2361 x 1568 pixels; centered on the macula; fundus photo; captured after pupil dilation
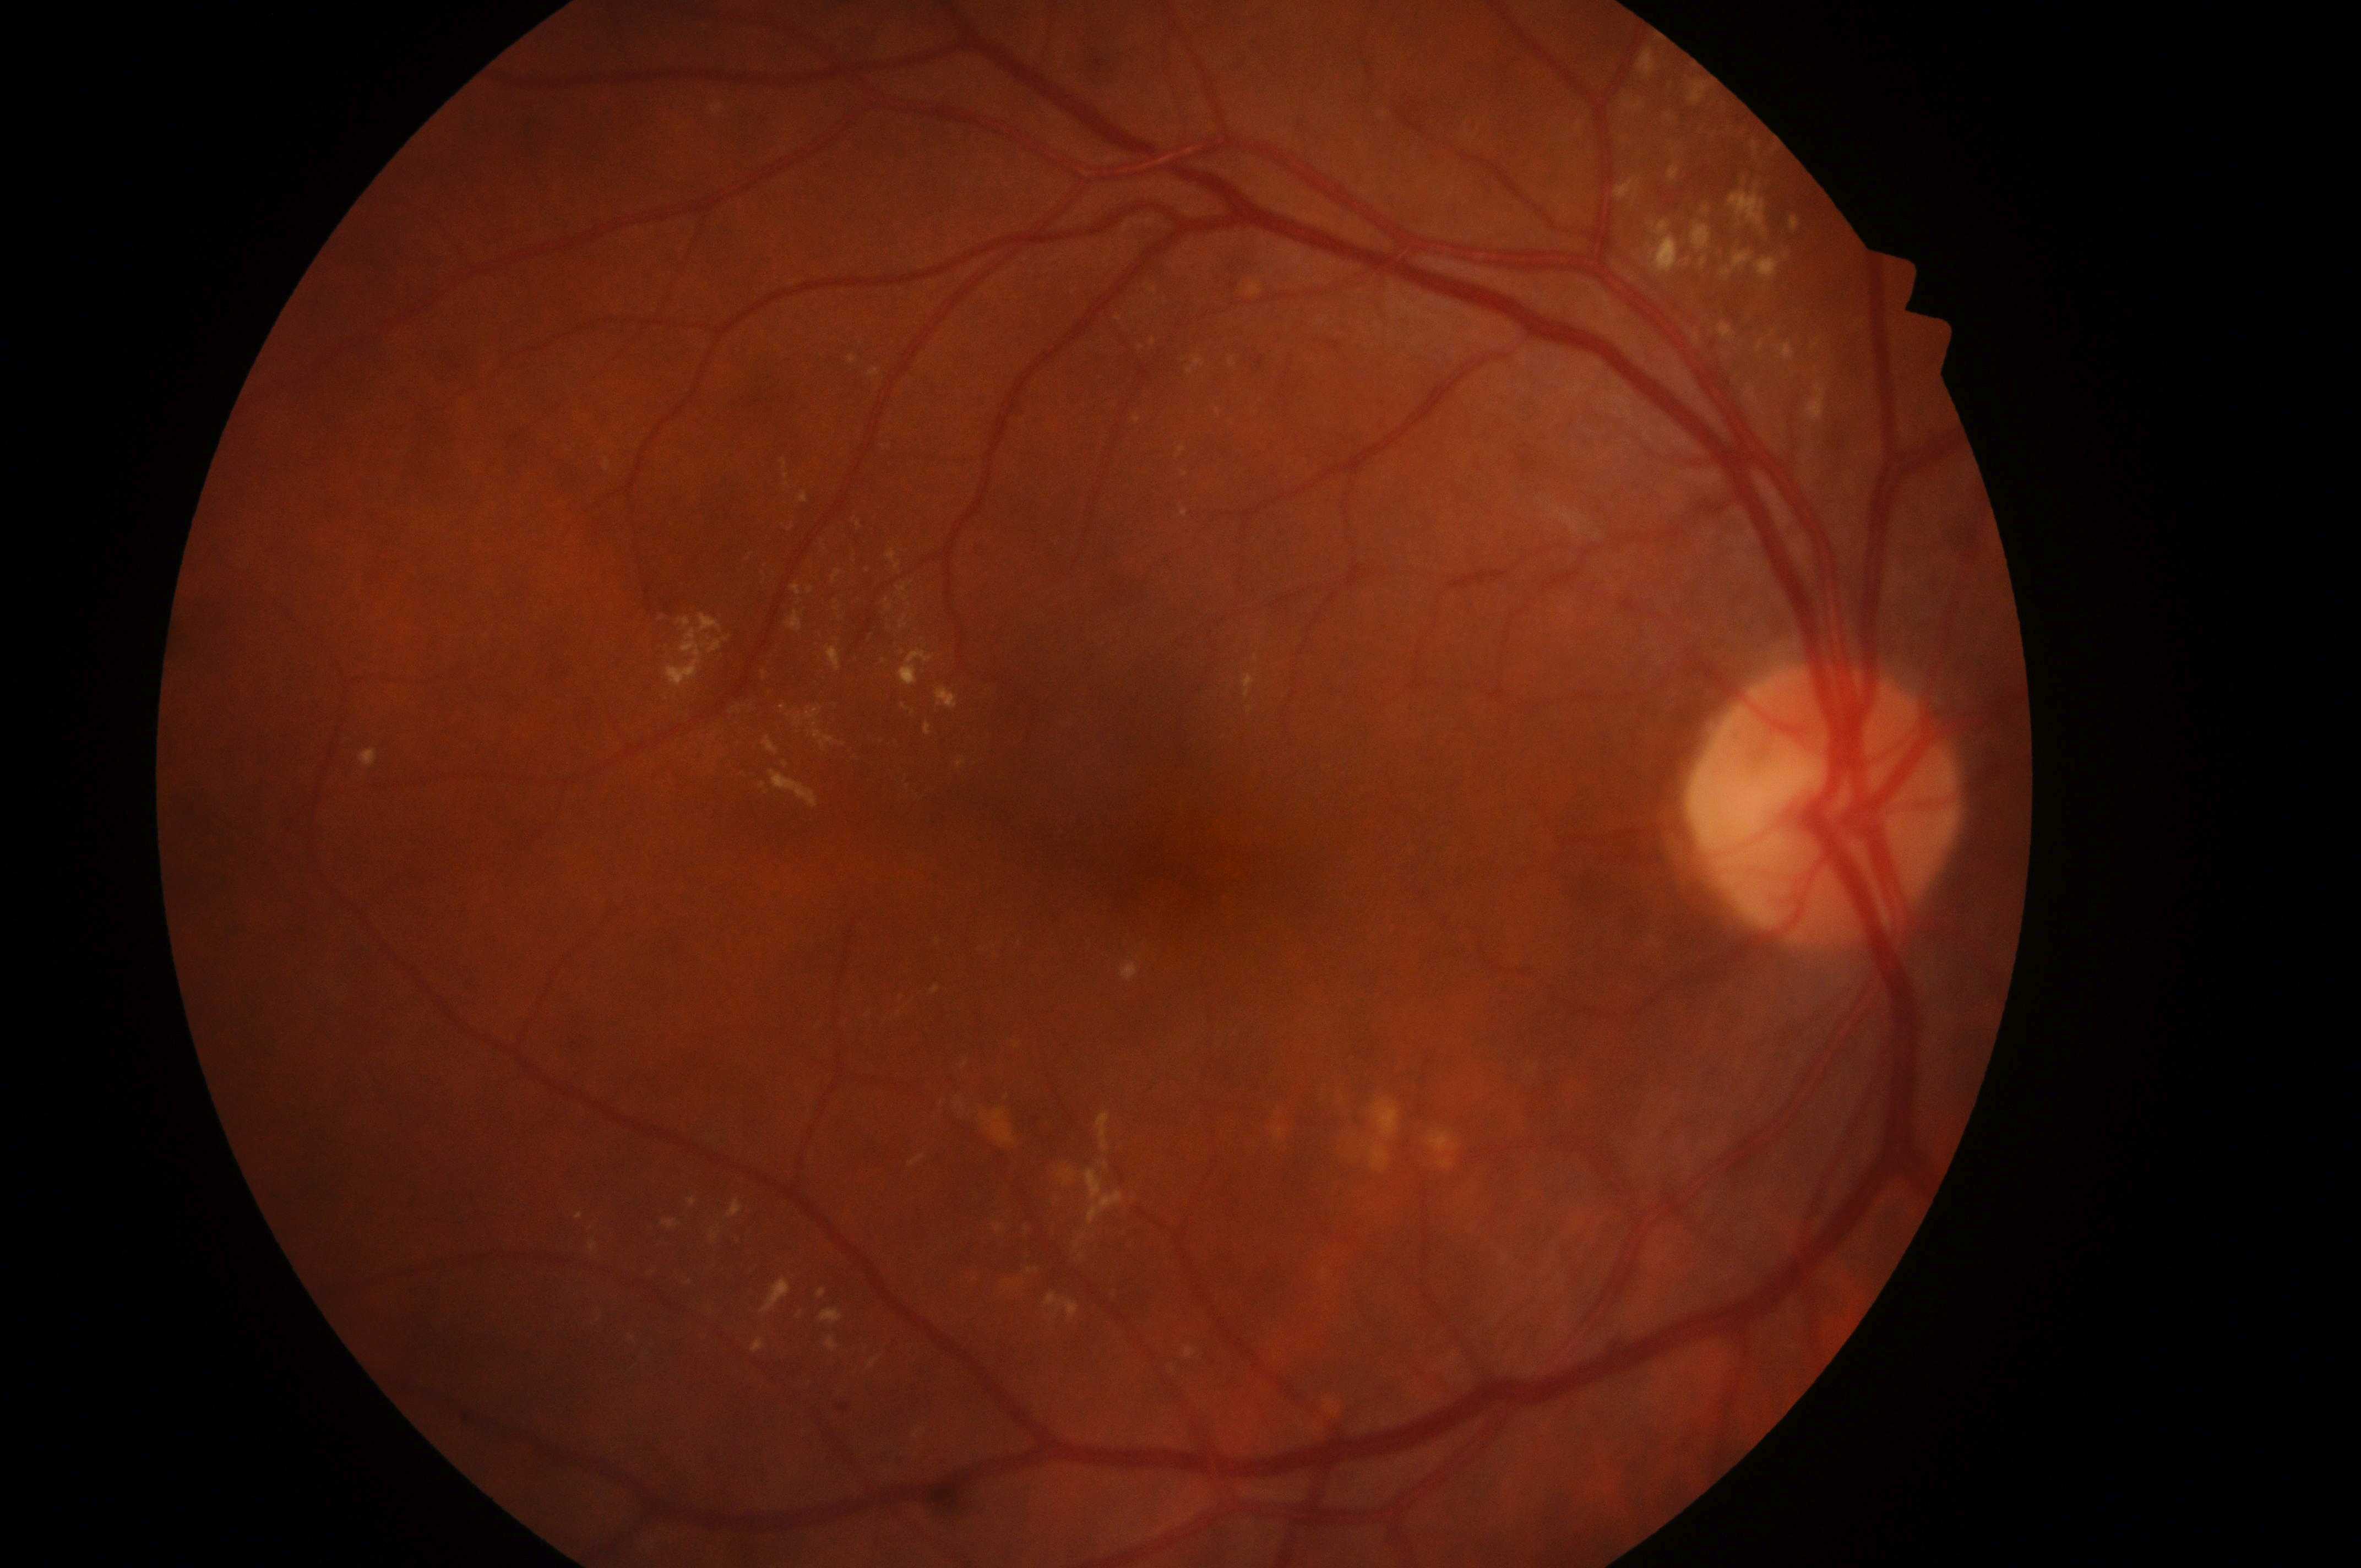
laterality = oculus dexter; DR class = non-proliferative diabetic retinopathy; DME grade = 2; DR = 2/4; the optic disc = (x=1821, y=814); fovea centralis = (x=1151, y=864).